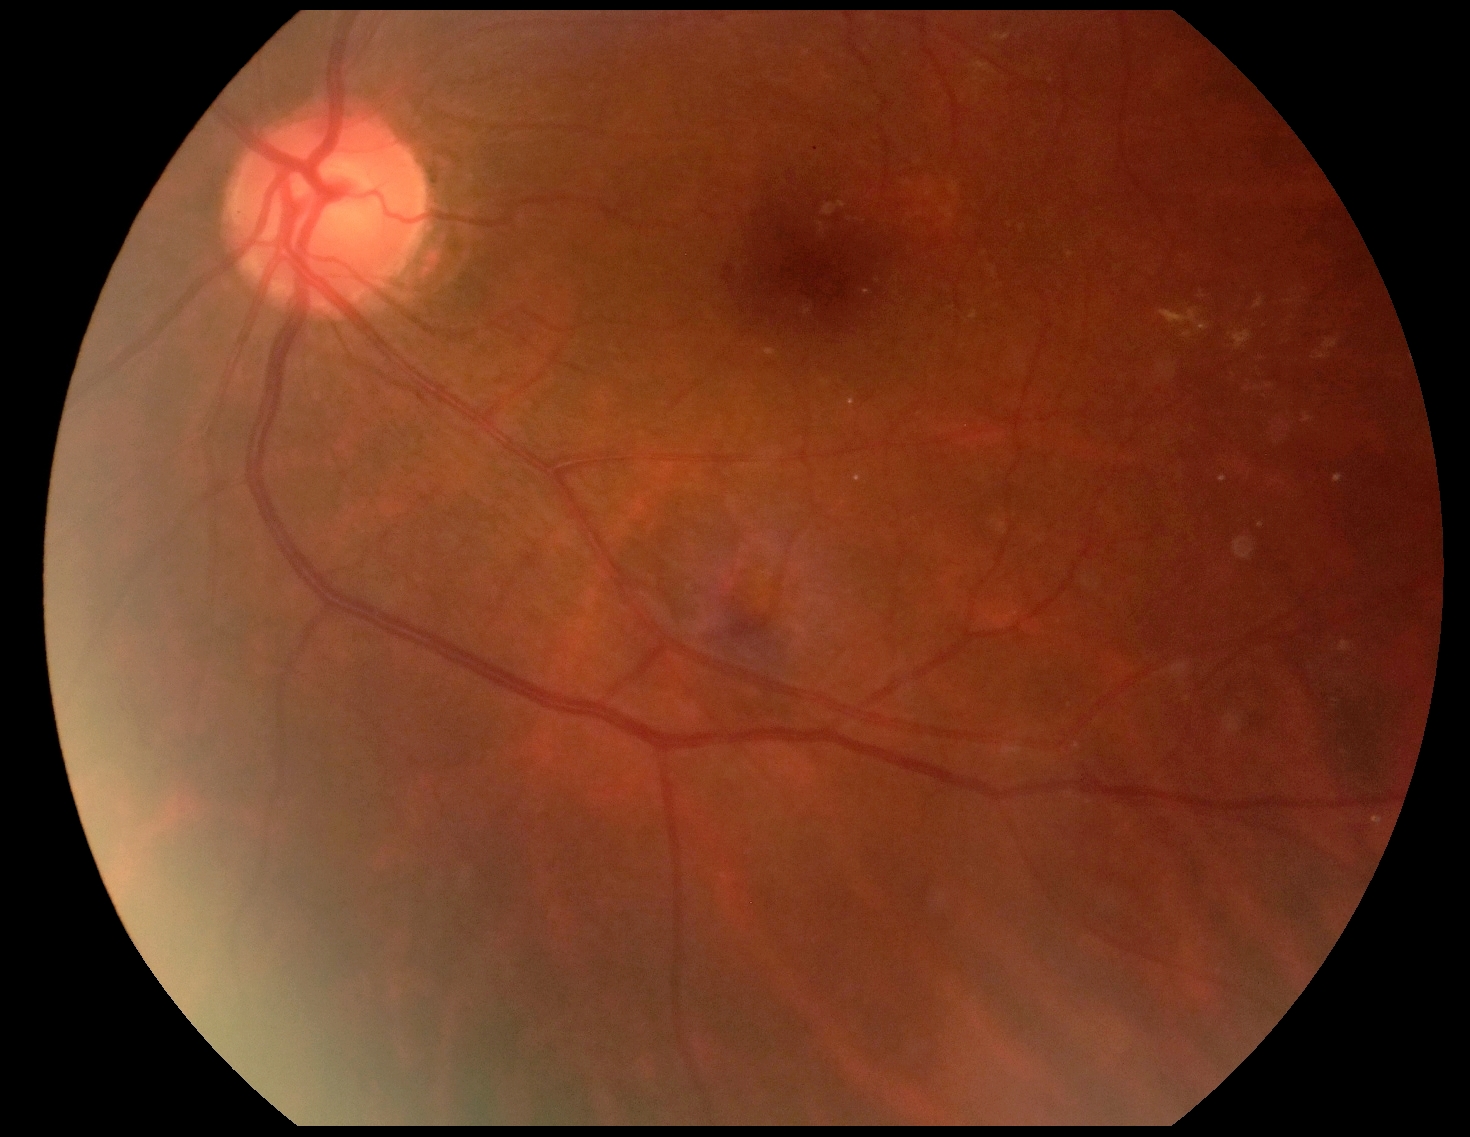
Disease class: non-proliferative diabetic retinopathy. Diabetic retinopathy severity is 2.